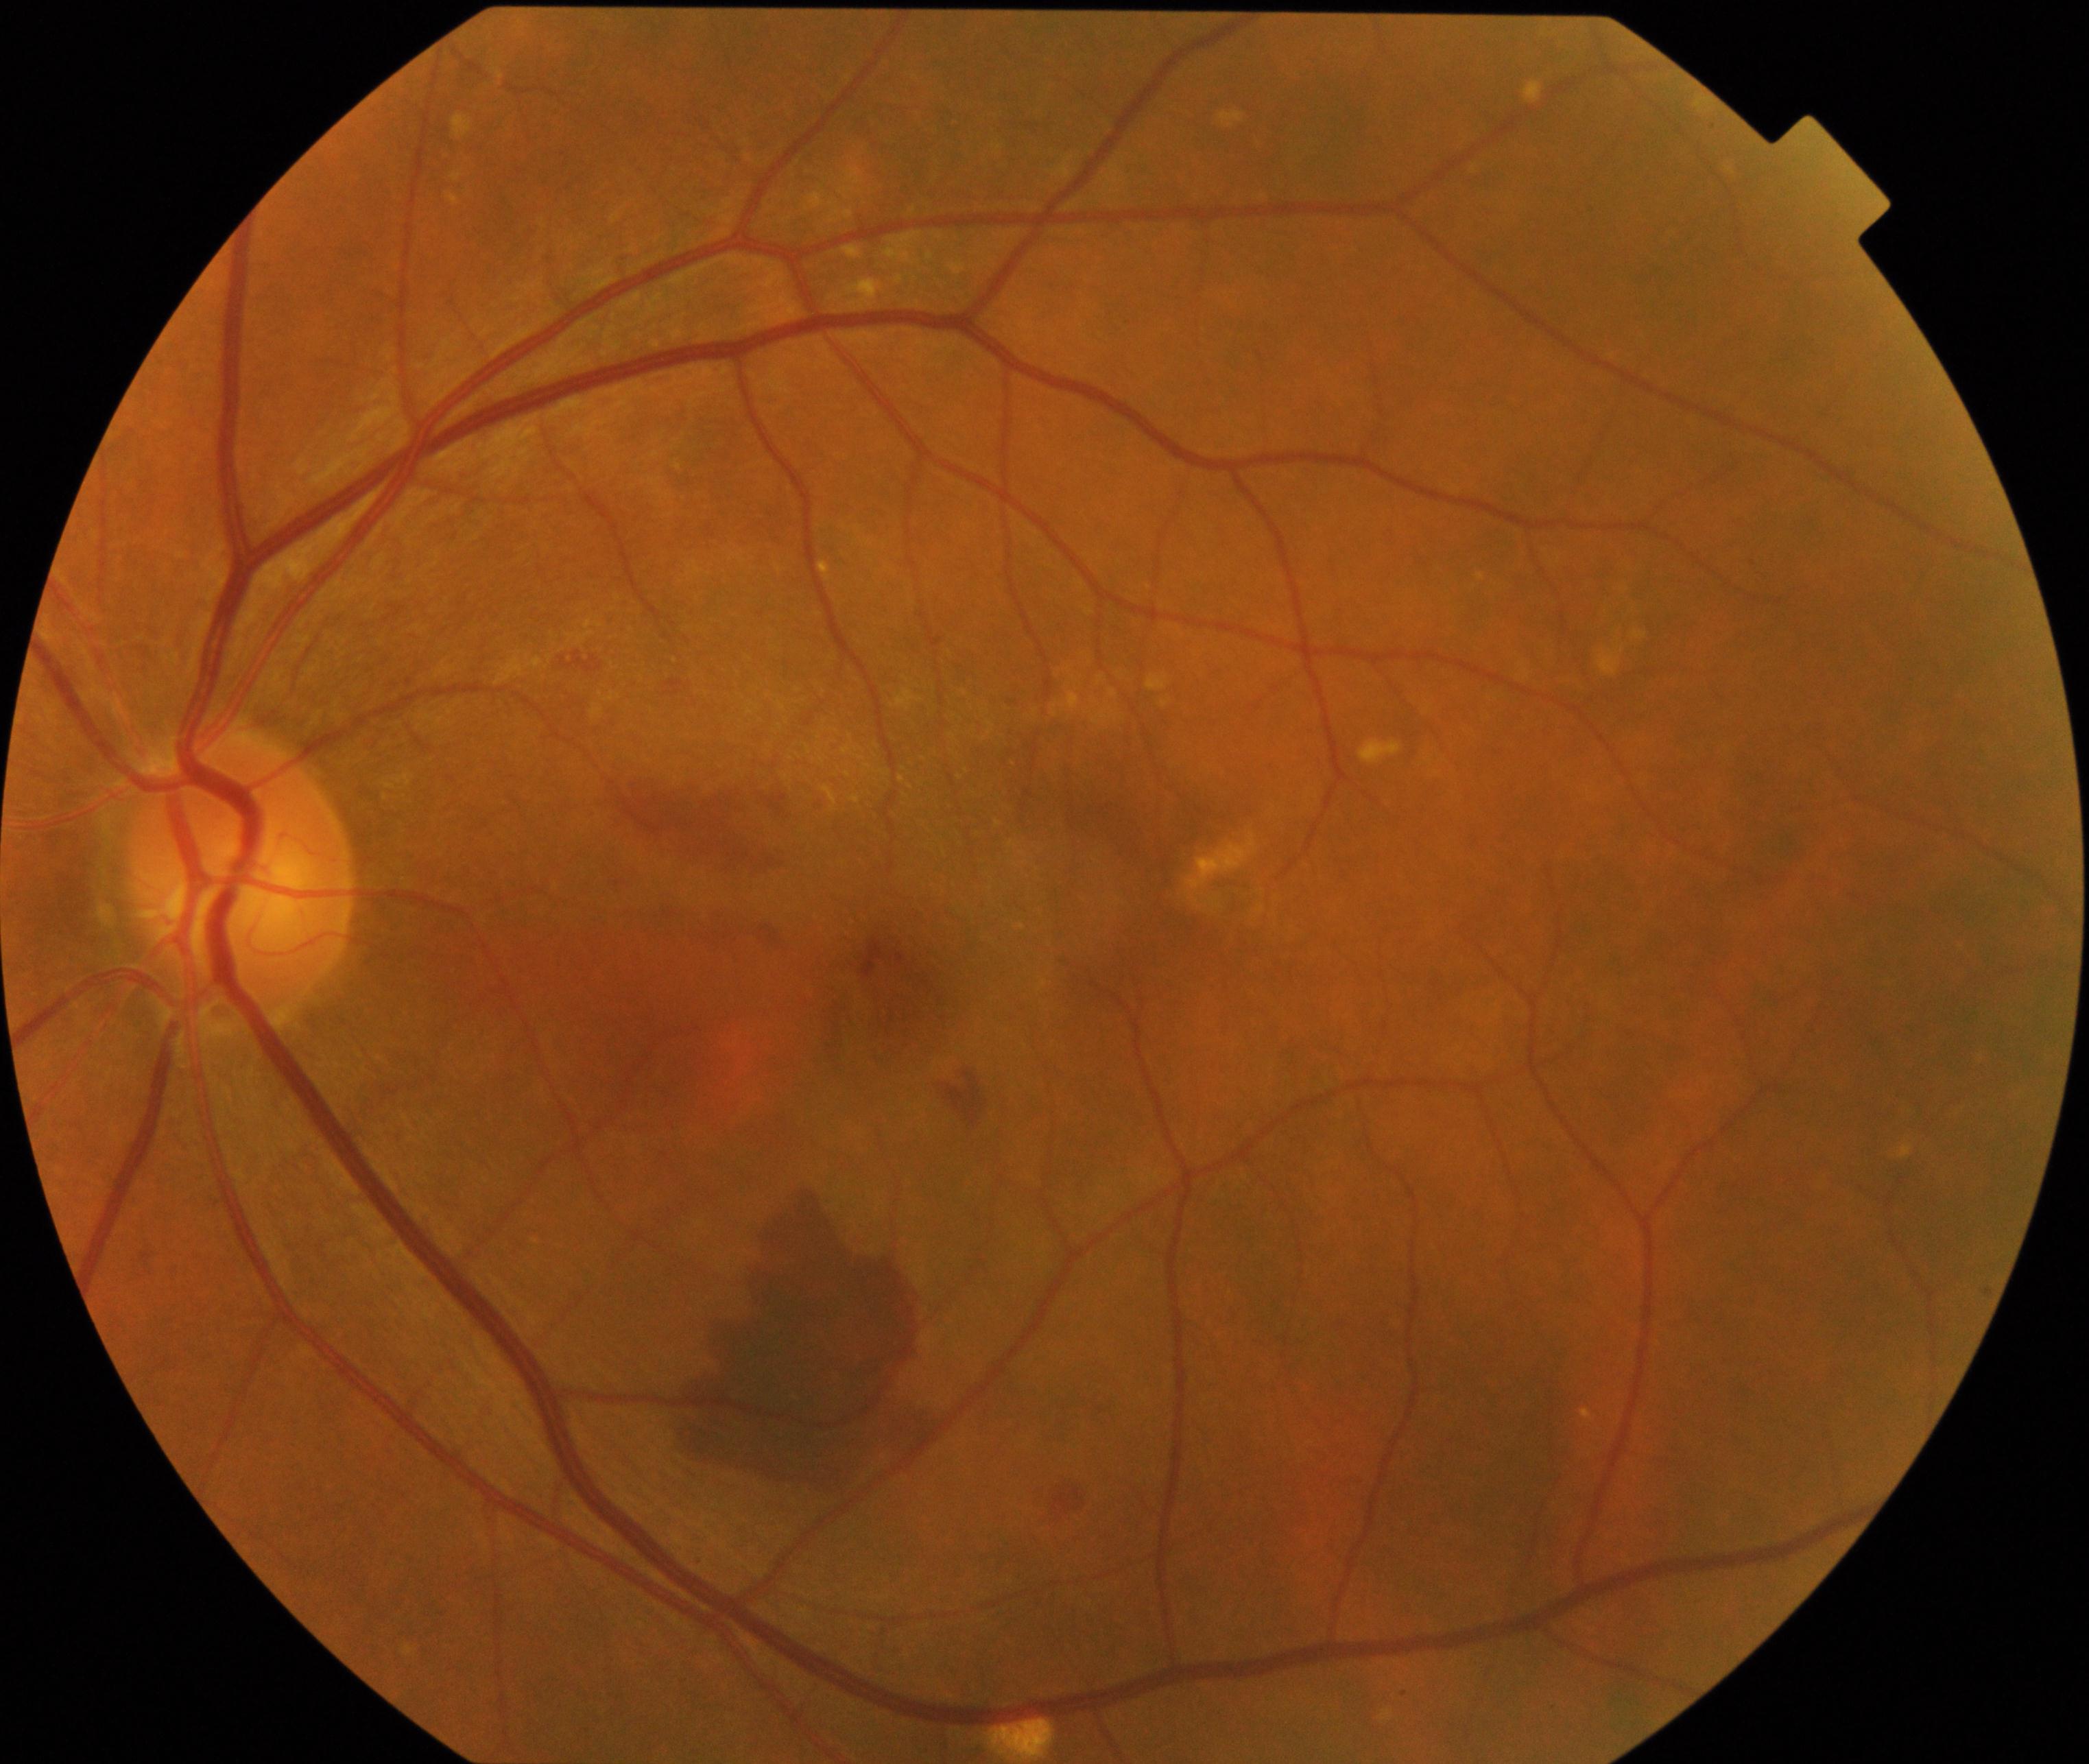
Primary finding: maculopathy.